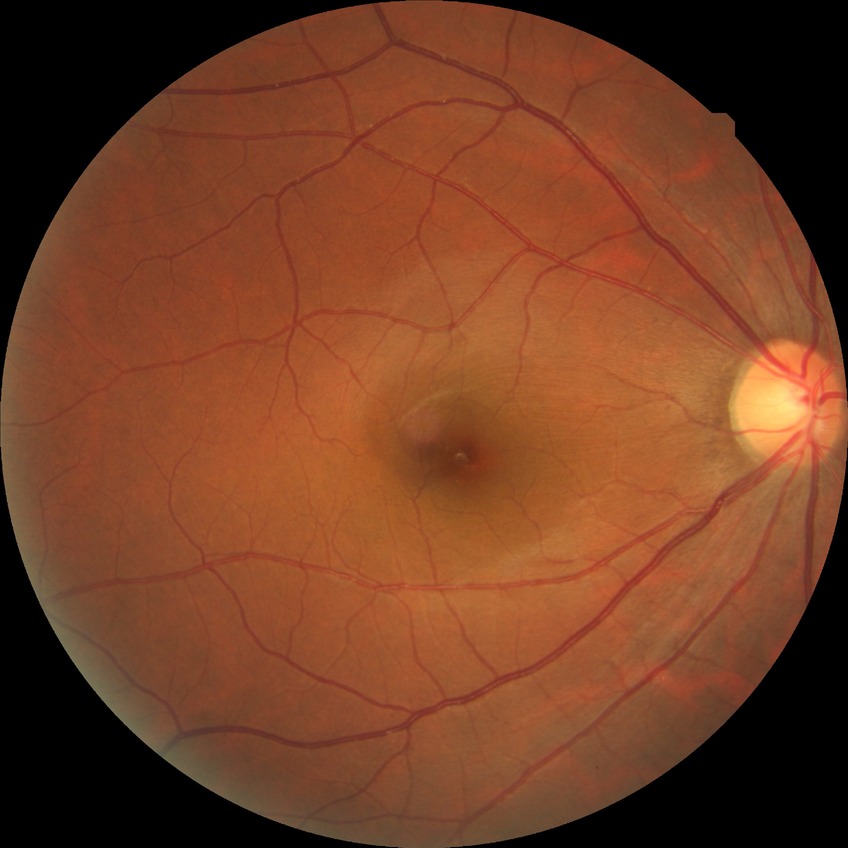
Davis stage: NDR.
No diabetic retinal disease findings.